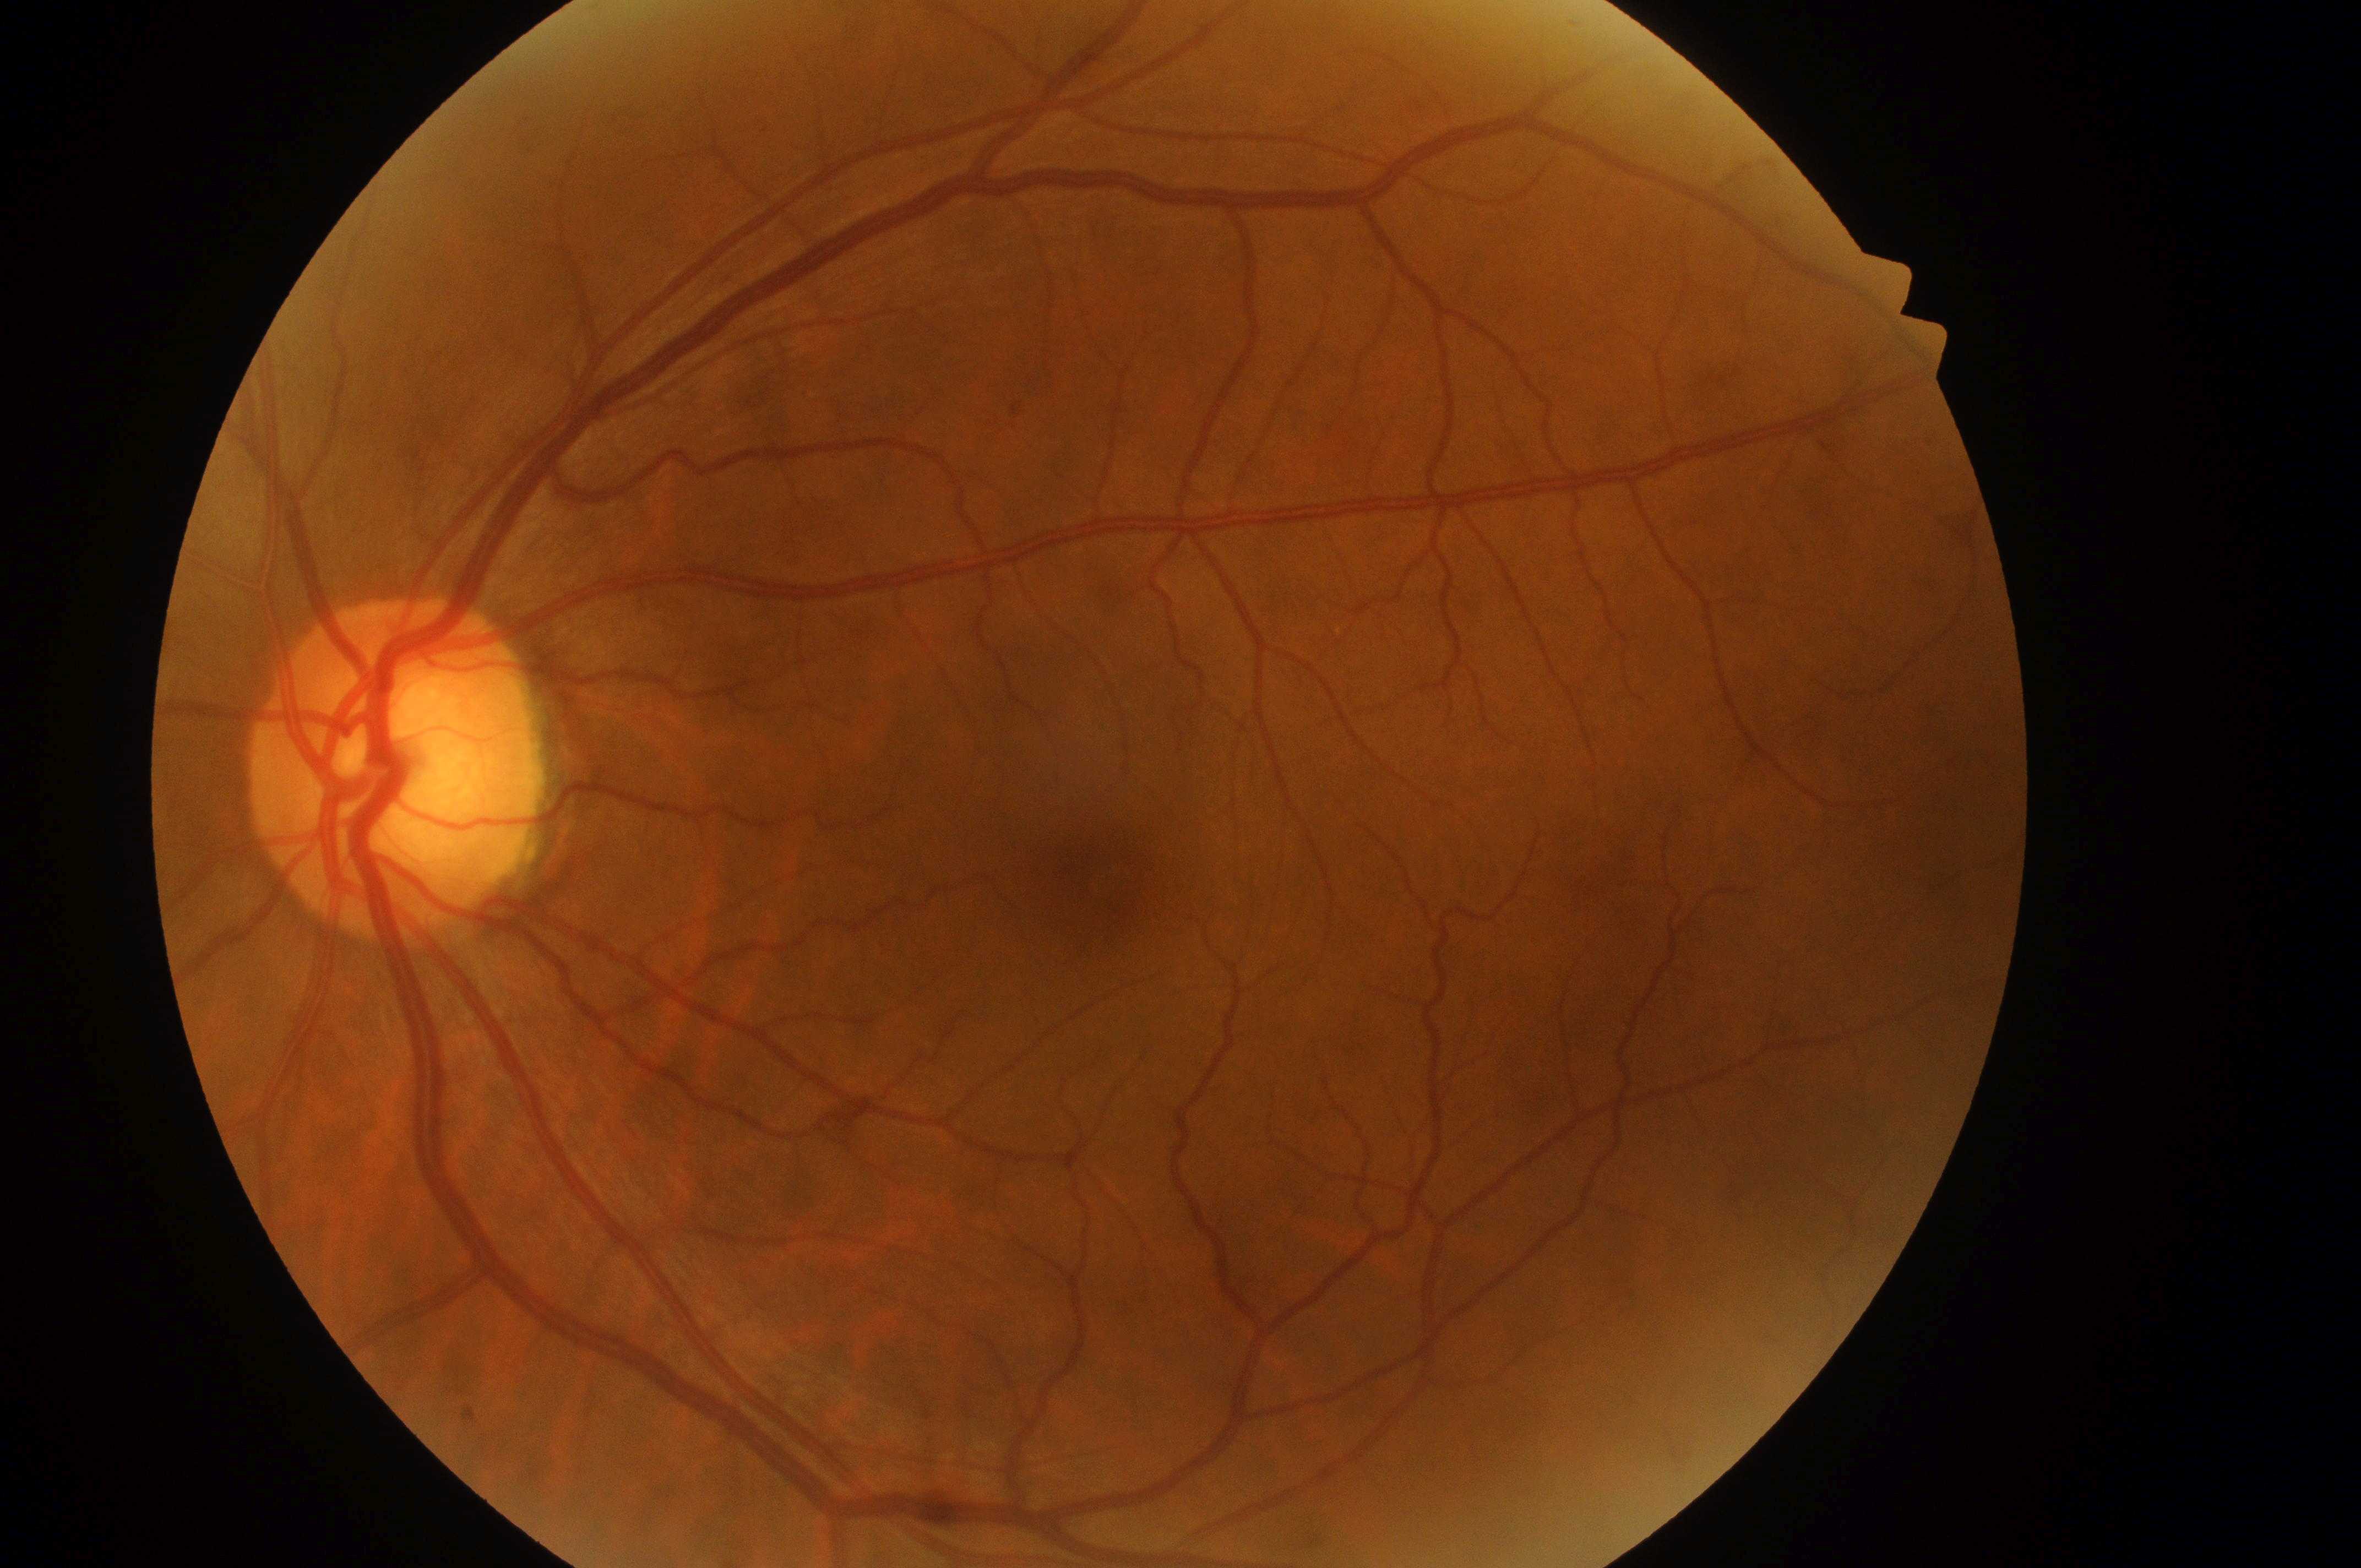

- eye: OS
- DME grade: low risk (1) — hard exudates present, but outside one disc diameter of the macula center
- DR: moderate NPDR (grade 2) — more than just microaneurysms but less than severe NPDR
- fovea center: 1101, 876
- optic disk: 389, 783